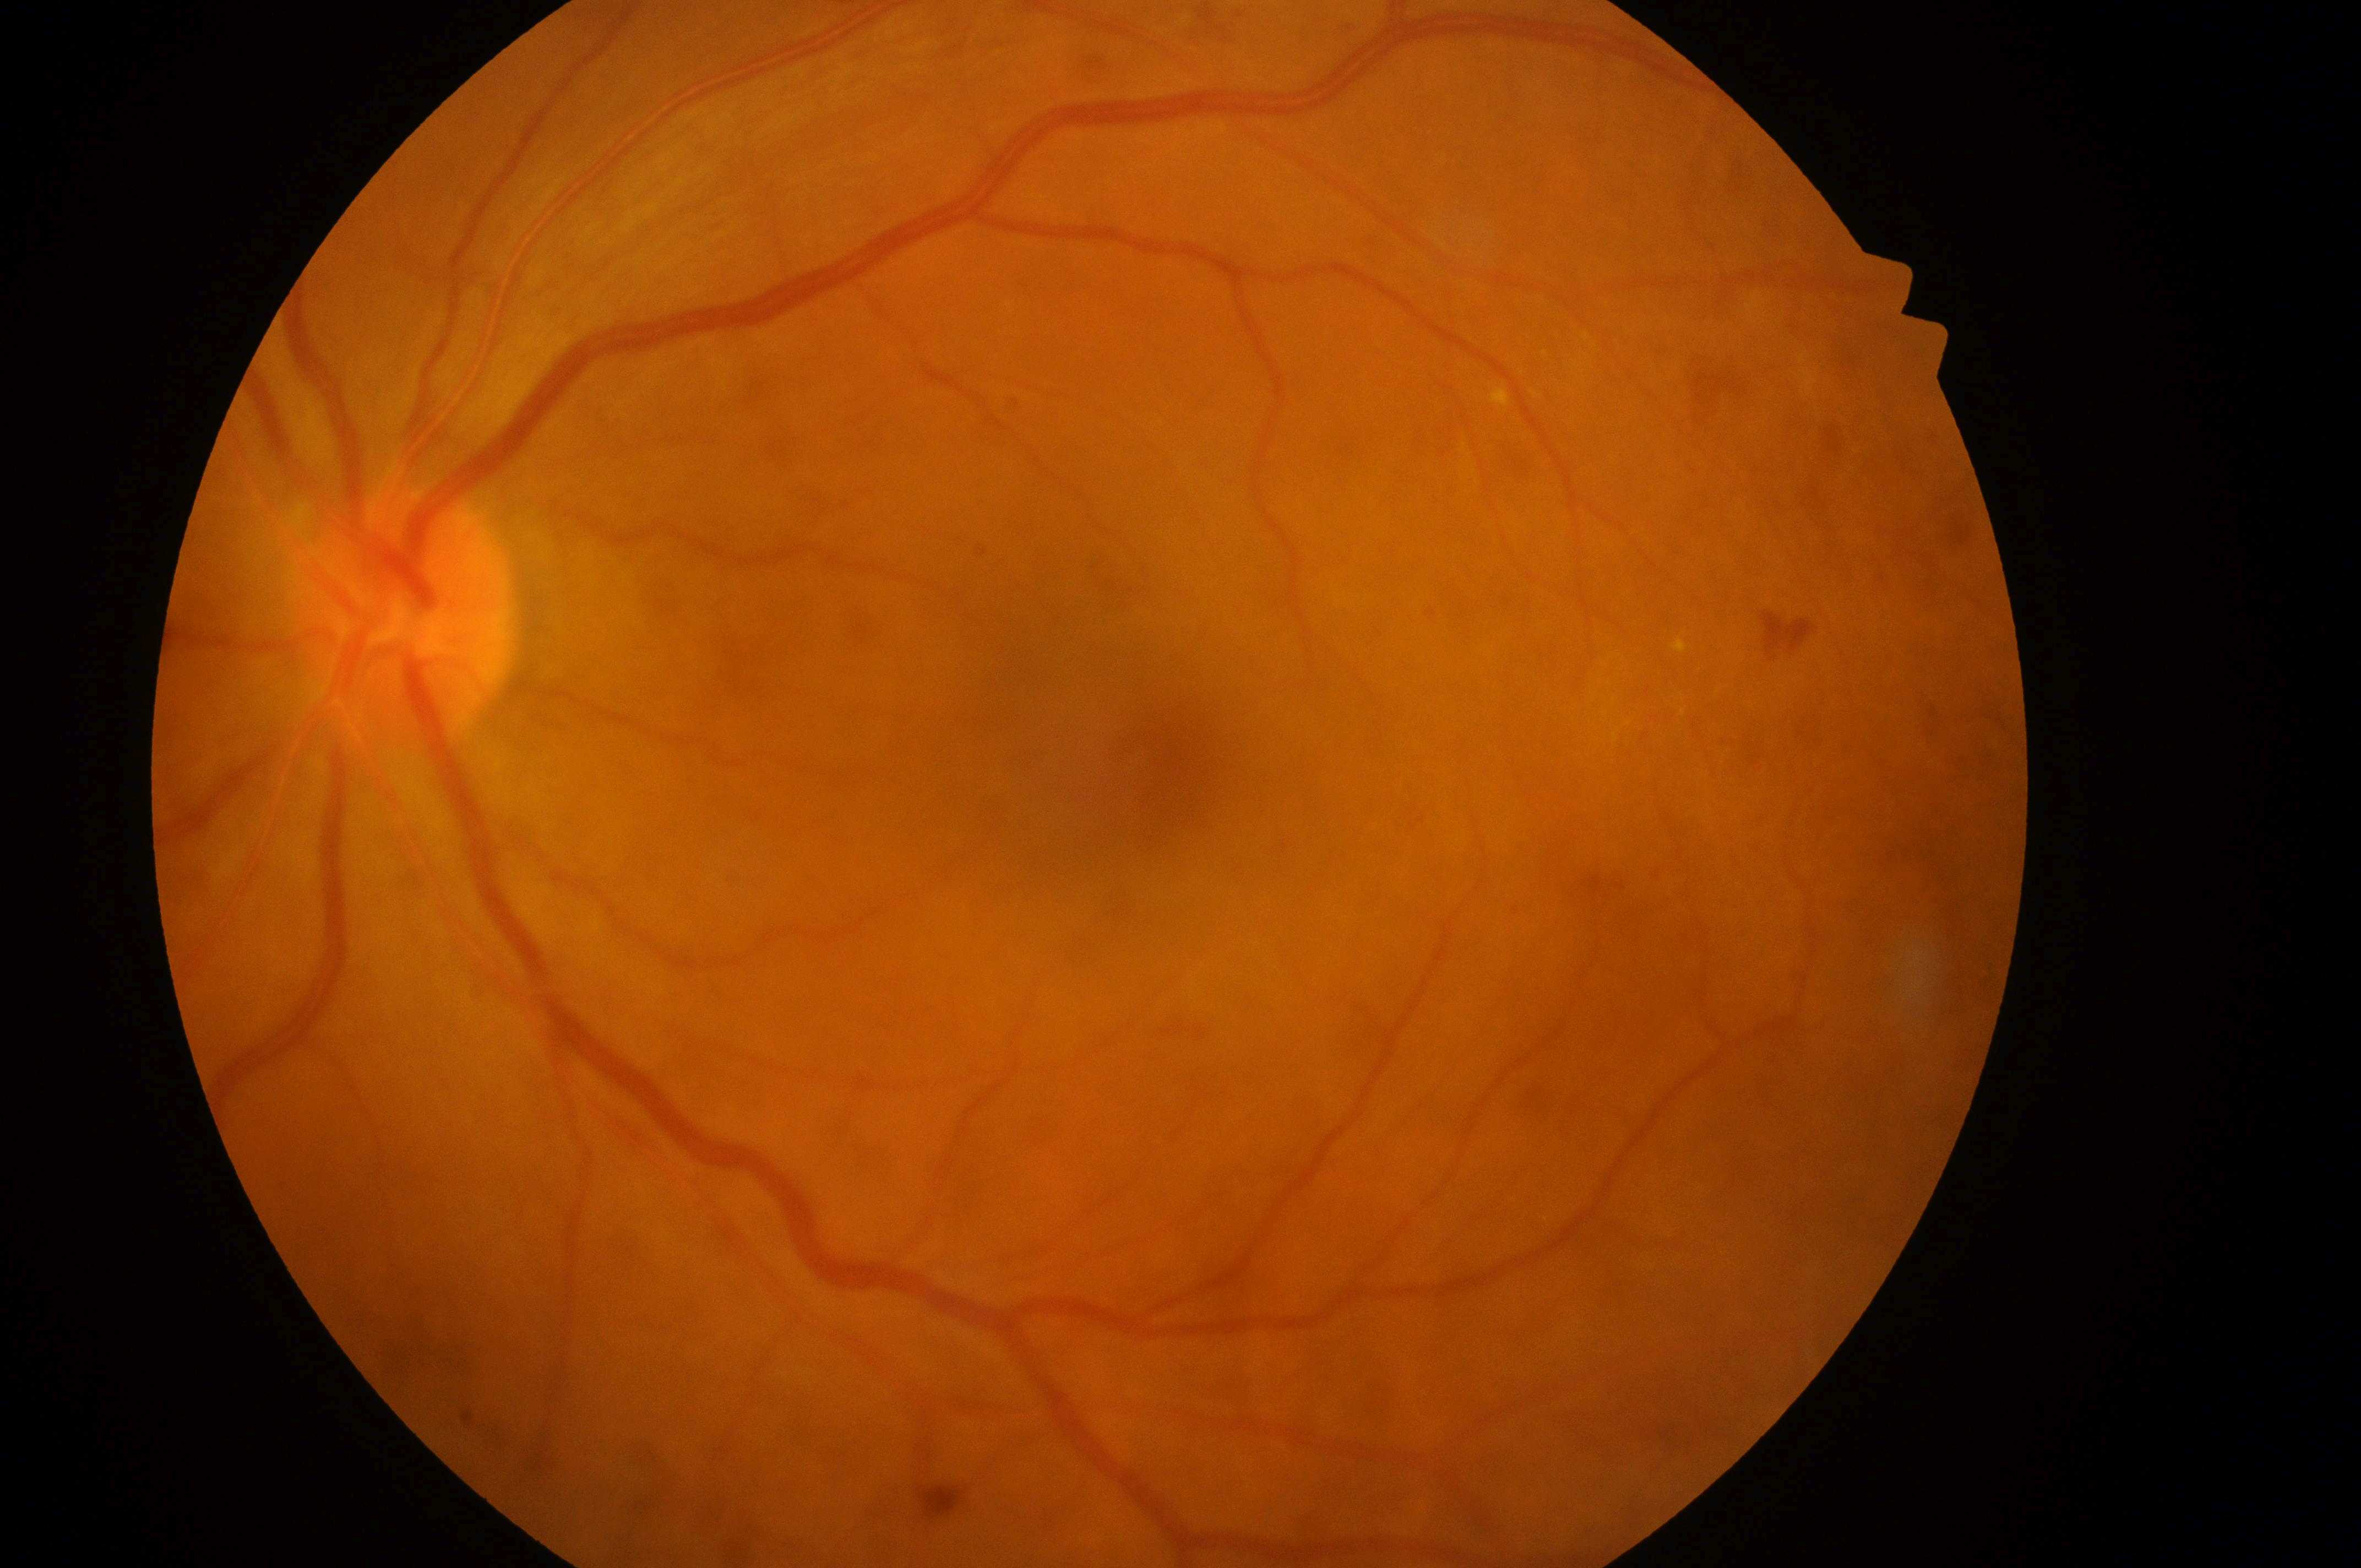
Macular edema is 1/2 — hard exudates present, but outside one disc diameter of the macula center.
Diabetic retinopathy grade: 2/4 — more than just microaneurysms but less than severe NPDR.
Eye: left.
Foveal center: (x: 1176, y: 771).
The ONH is at (x: 408, y: 624).